Color fundus photograph · 45-degree field of view · 2352x1568px.
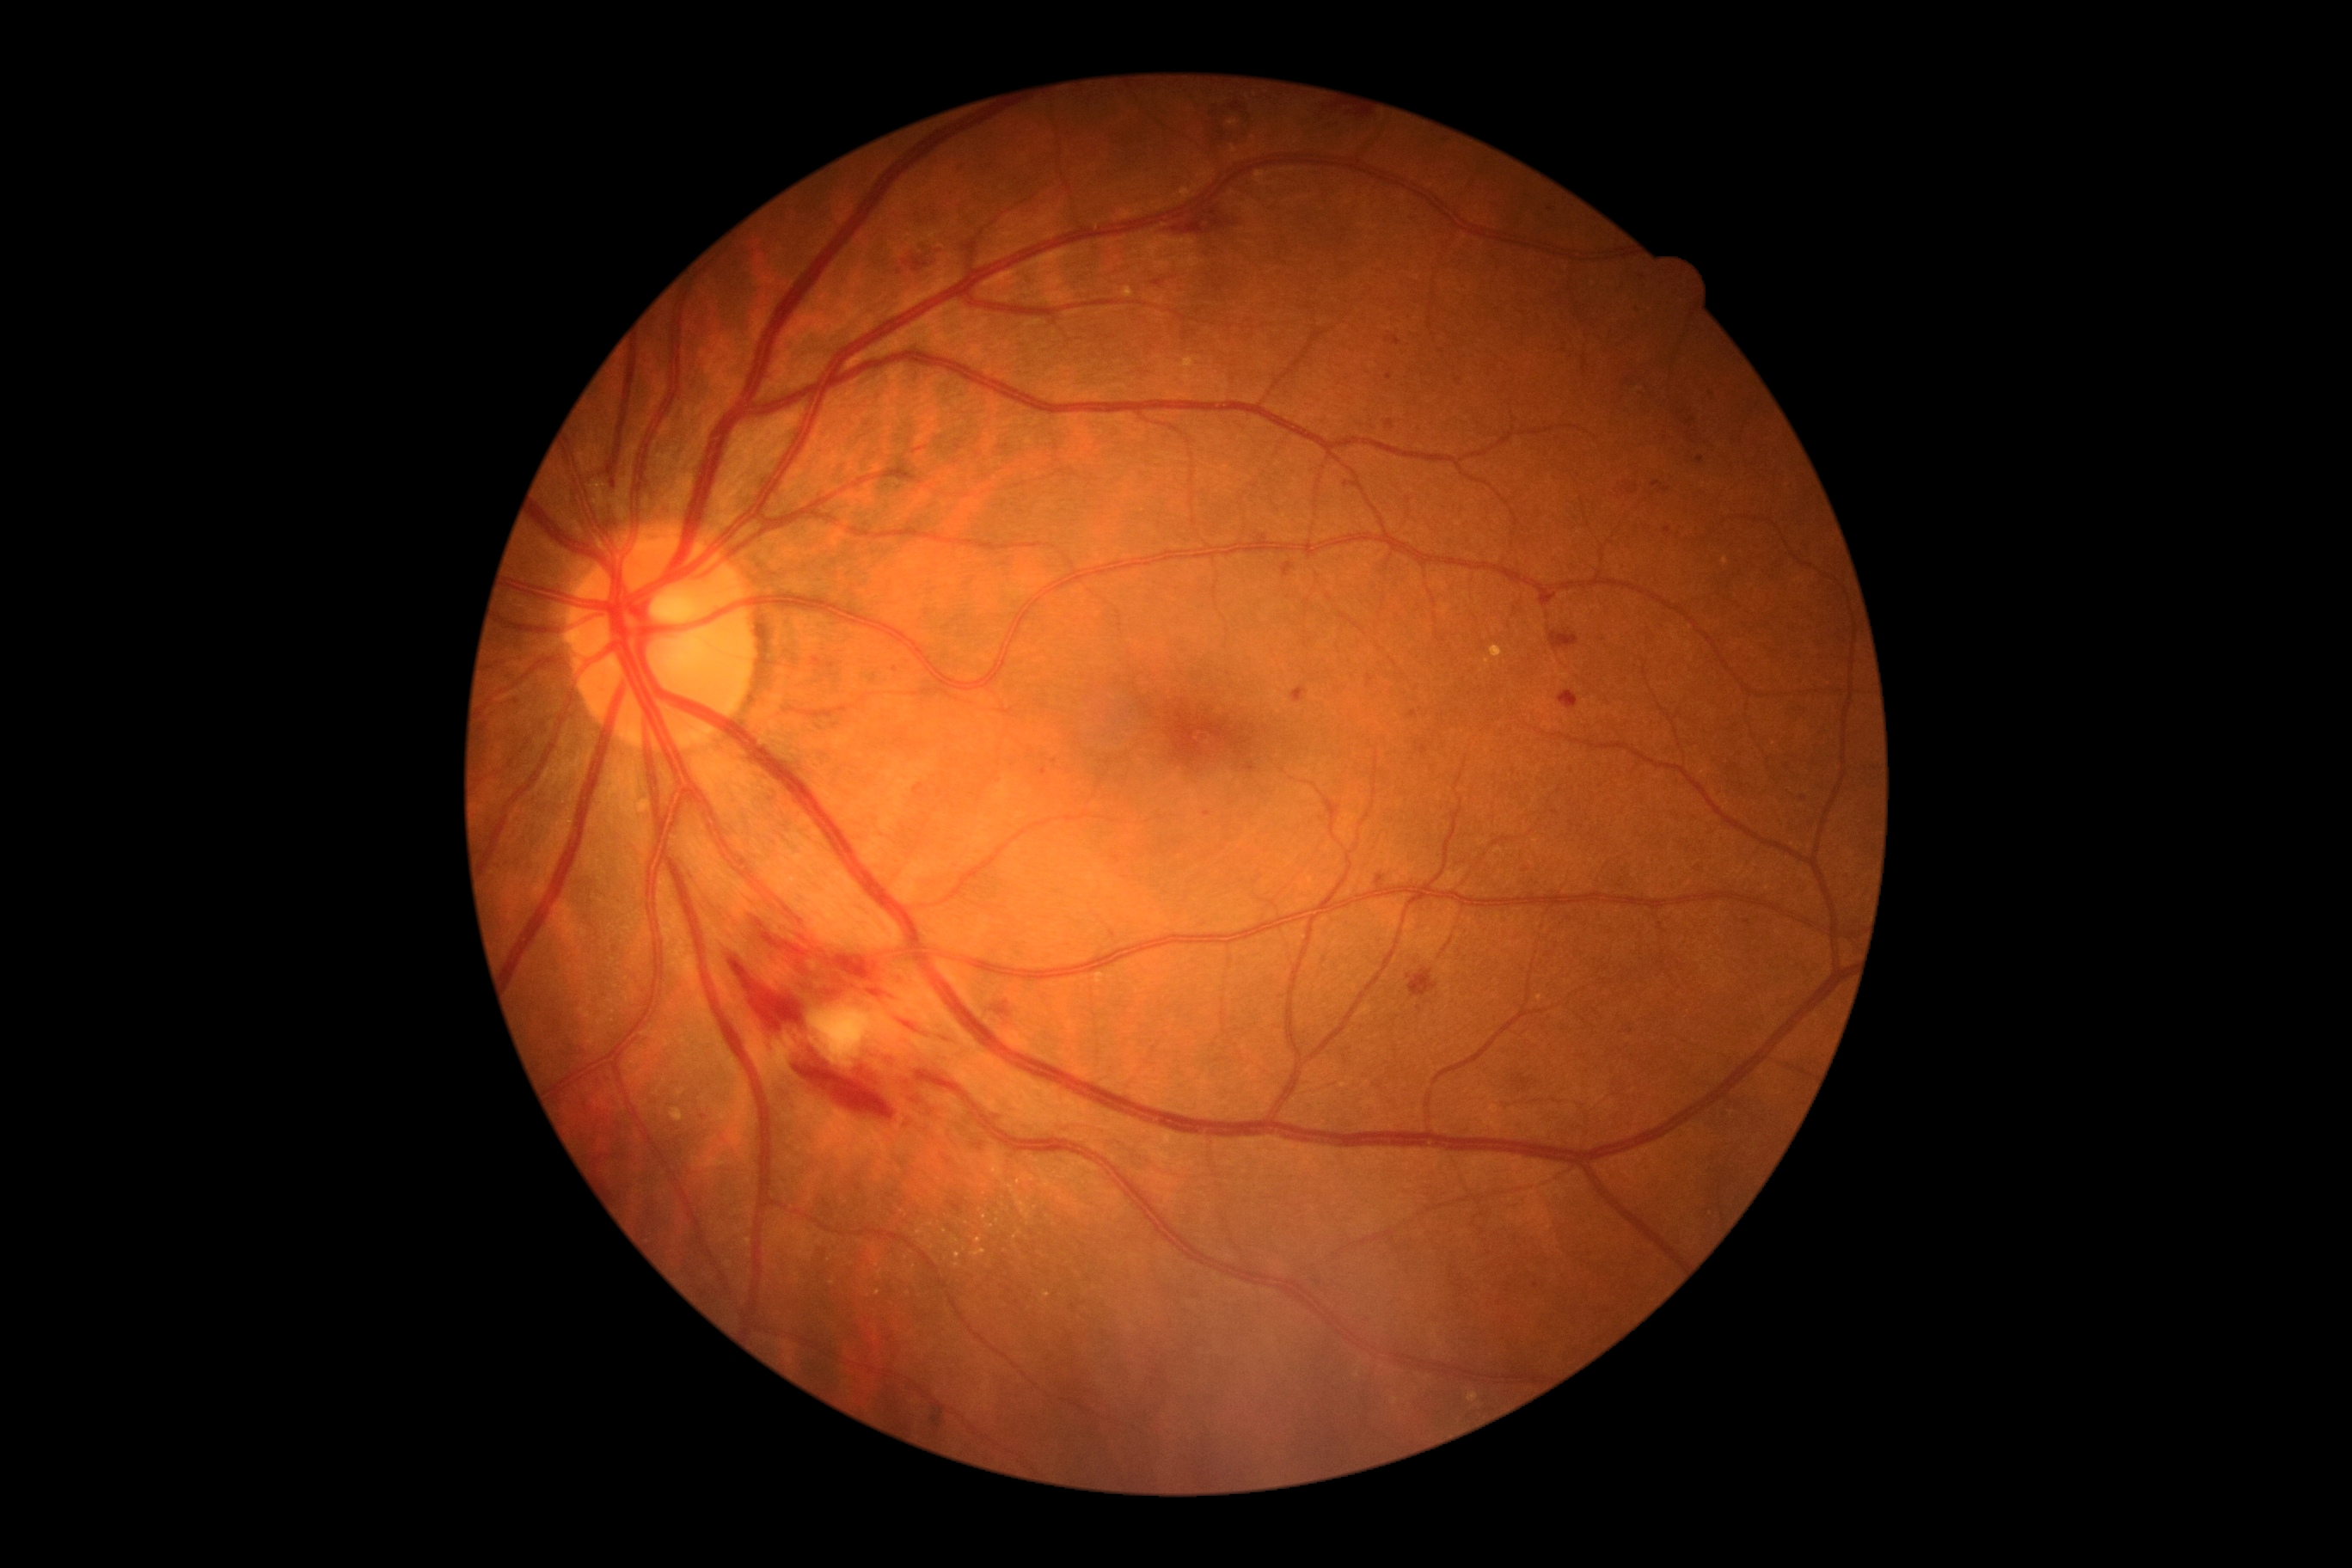 dr_category: non-proliferative diabetic retinopathy
dr_grade: moderate non-proliferative diabetic retinopathy (grade 2) — more than just microaneurysms but less than severe NPDR